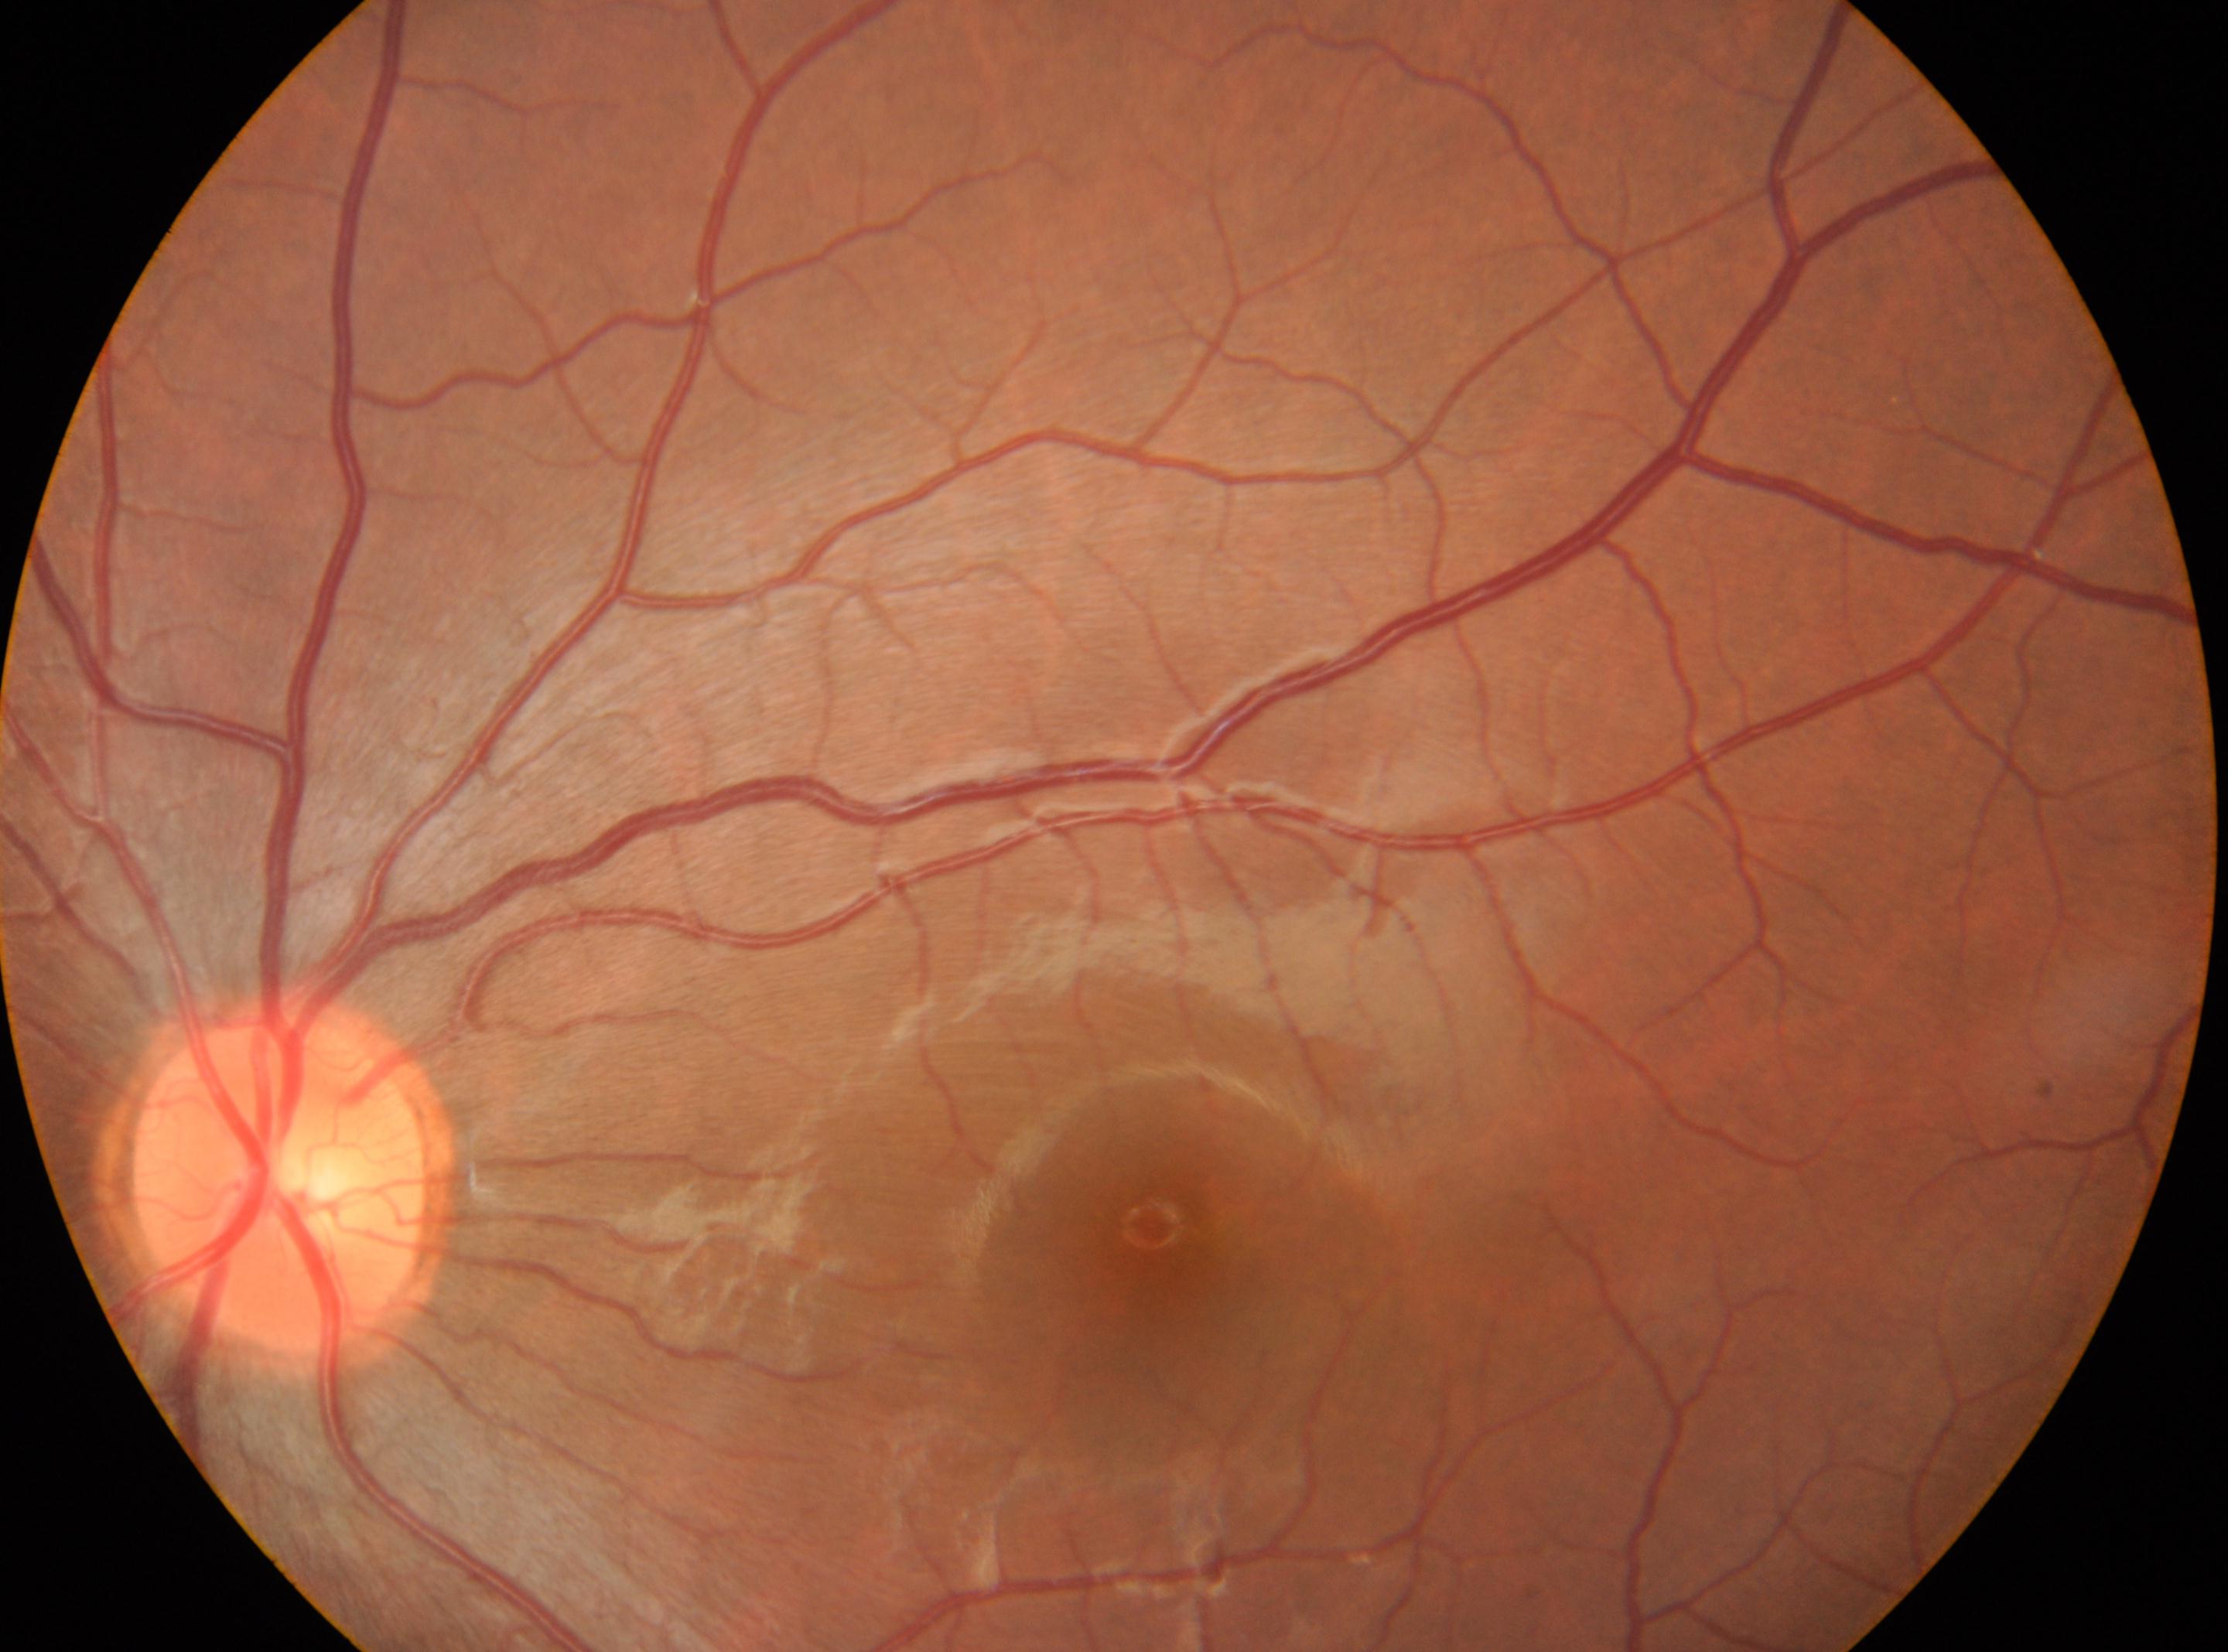 • fovea: (x: 1168, y: 1248)
• optic disc: (x: 278, y: 1185)
• DR stage: no apparent diabetic retinopathy (grade 0) — no visible signs of diabetic retinopathy
• laterality: the left eye